Wide-field fundus photograph from neonatal ROP screening — 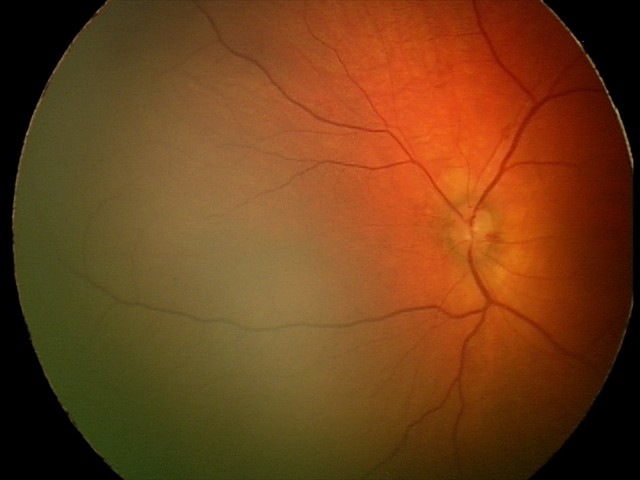 Assessment = retinal hemorrhages.